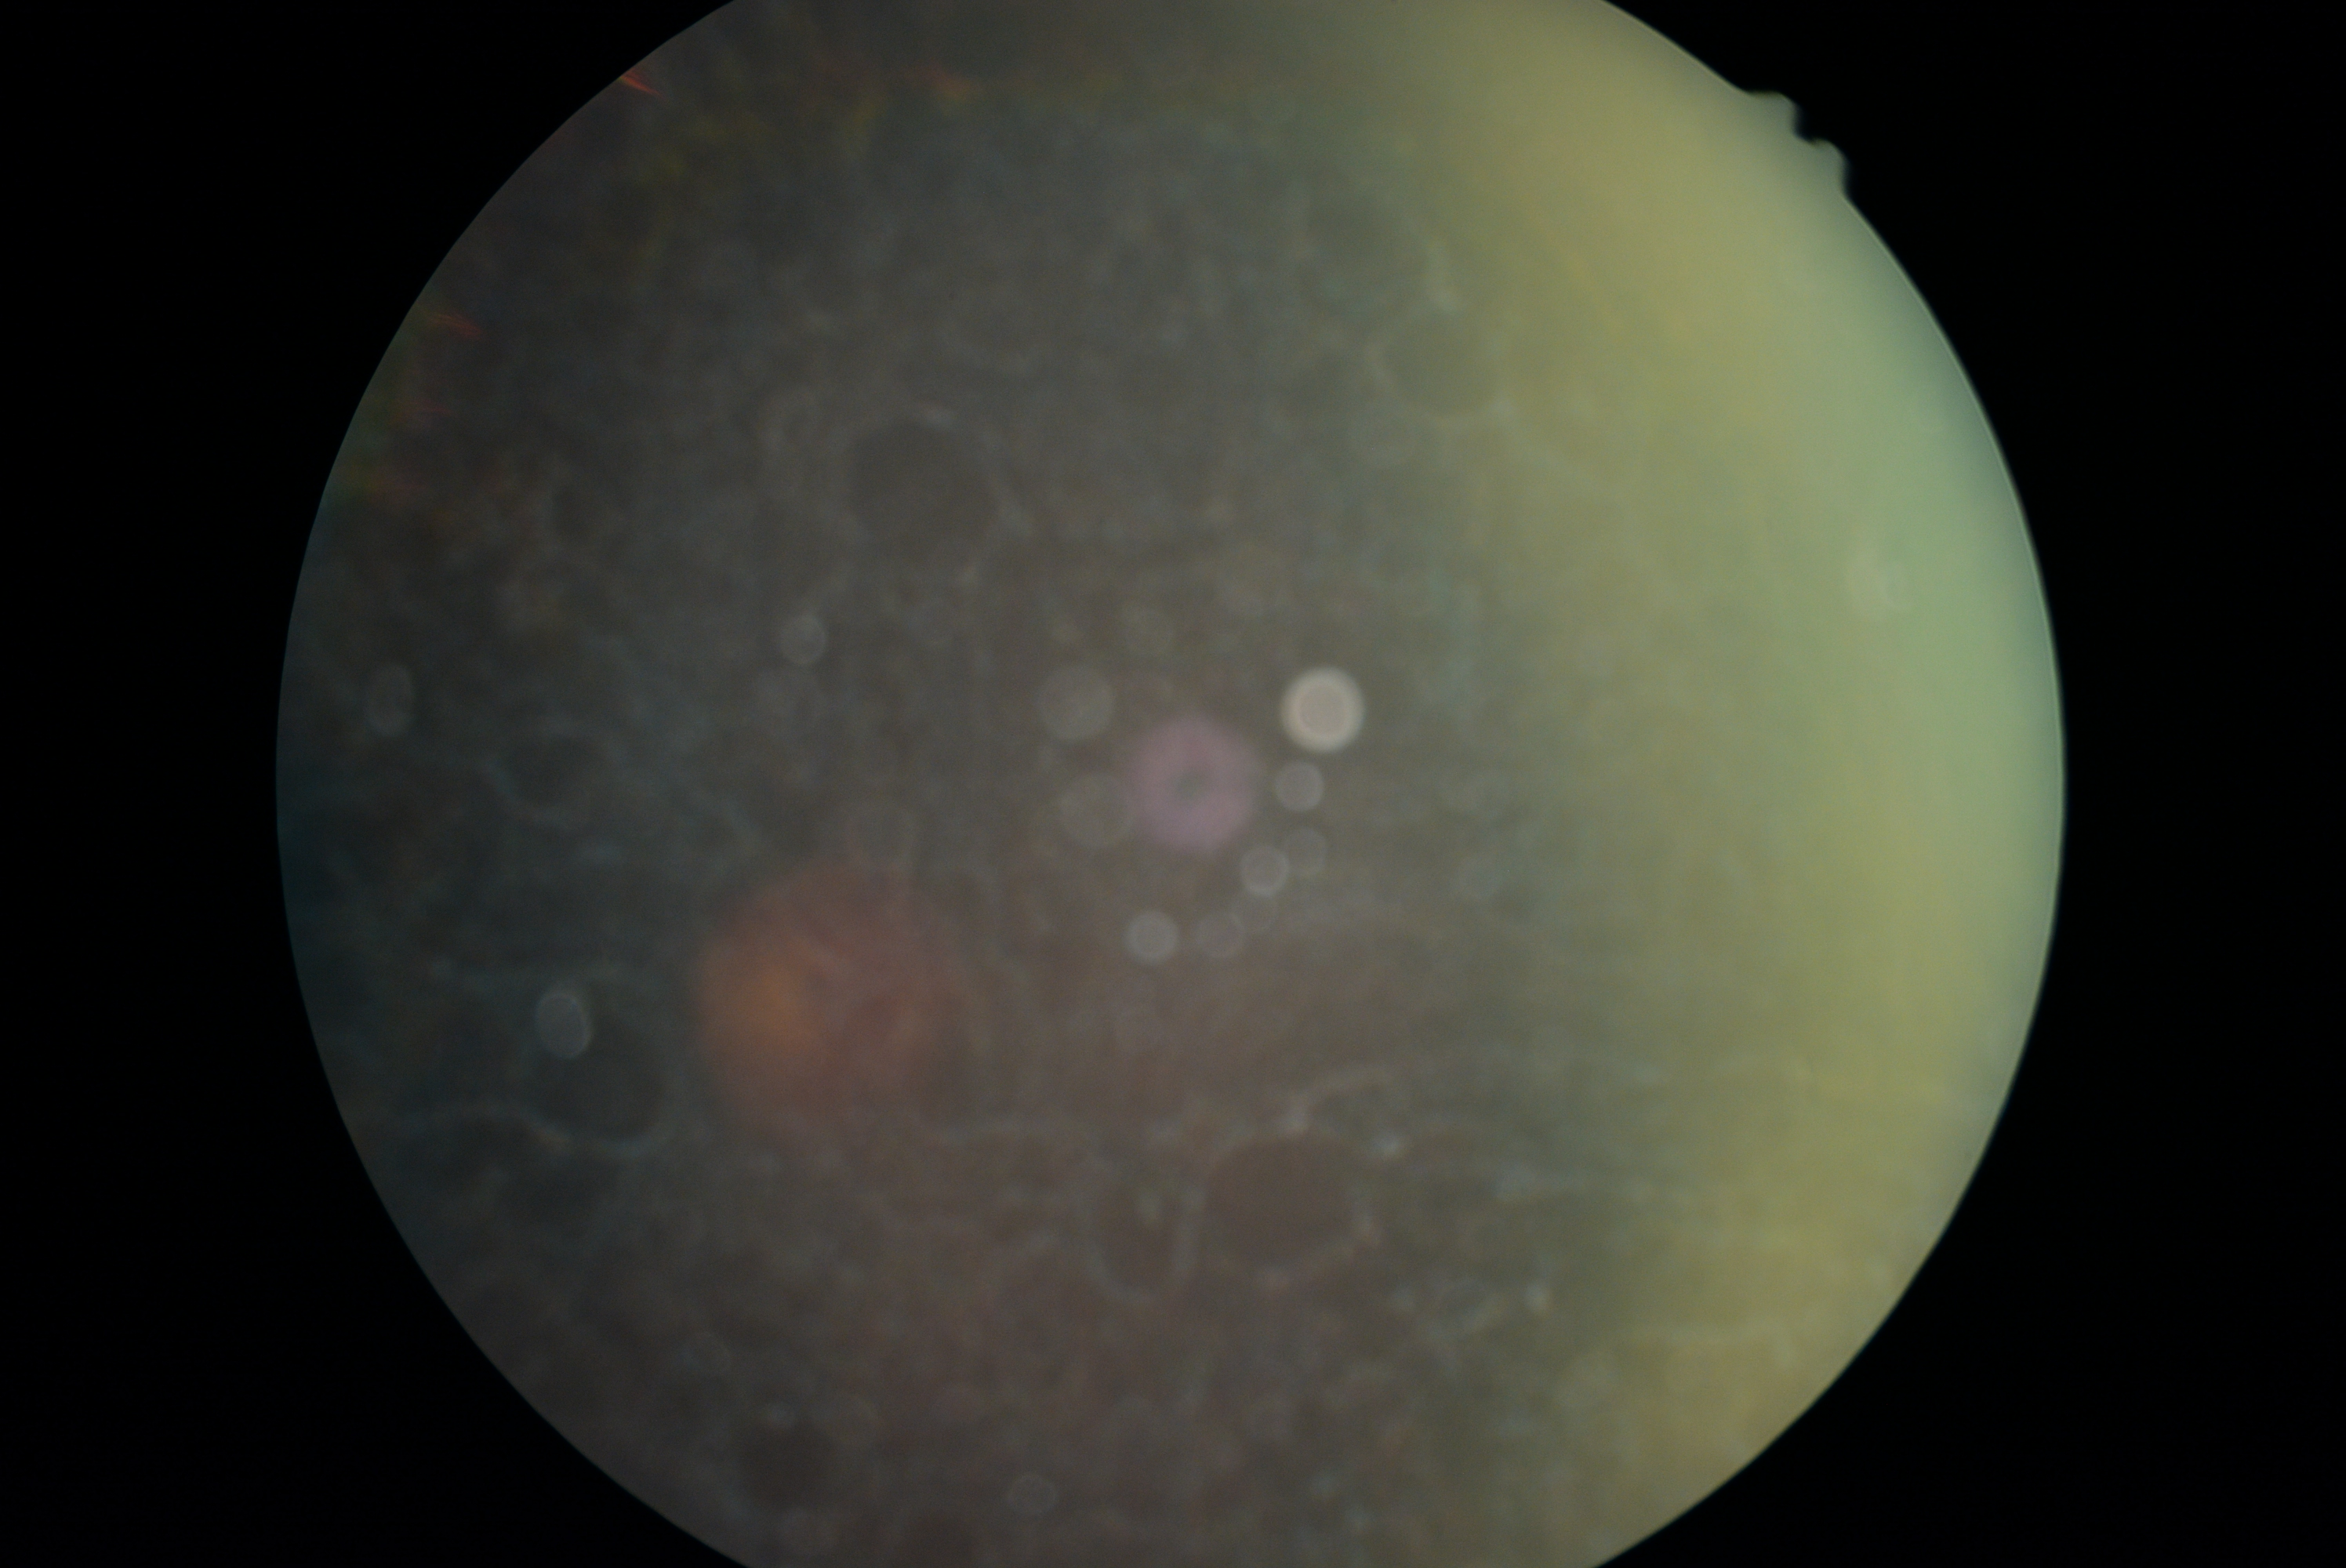 Image quality is insufficient for diabetic retinopathy assessment.
Diabetic retinopathy (DR) is ungradable due to poor image quality.